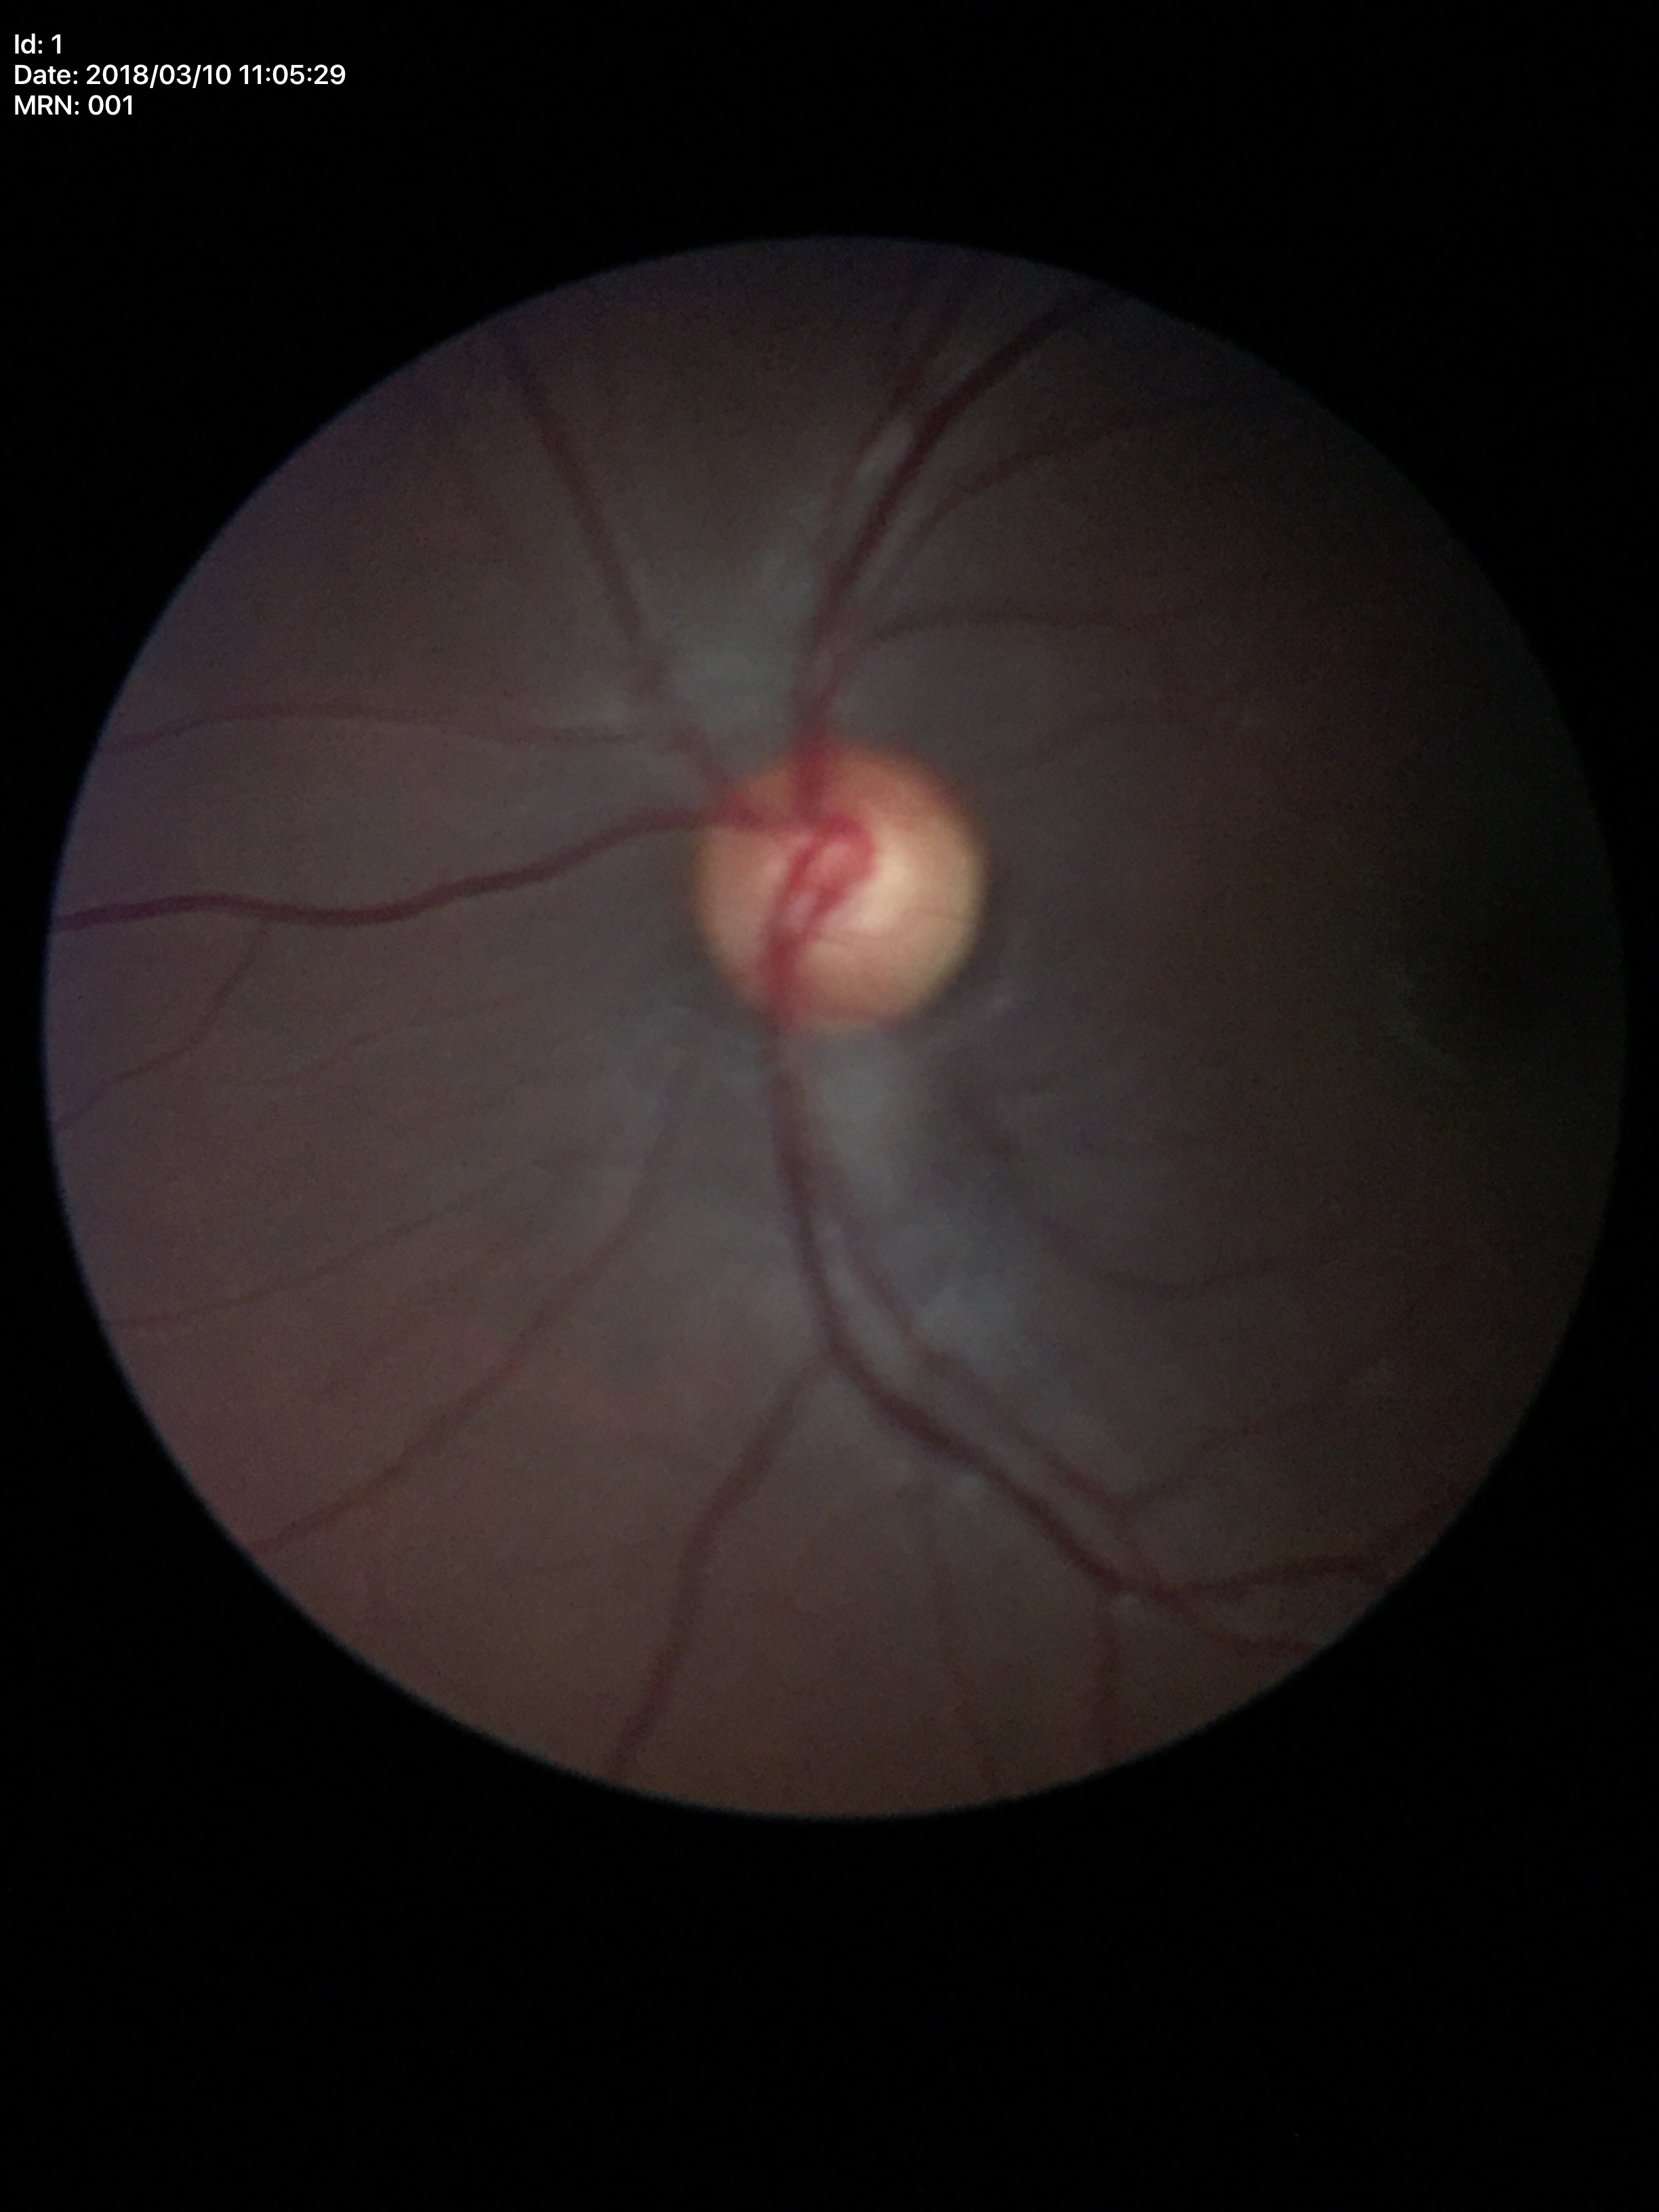

Glaucoma screening impression: negative. VCDR of 0.53. HCDR: 0.55.